CFP:
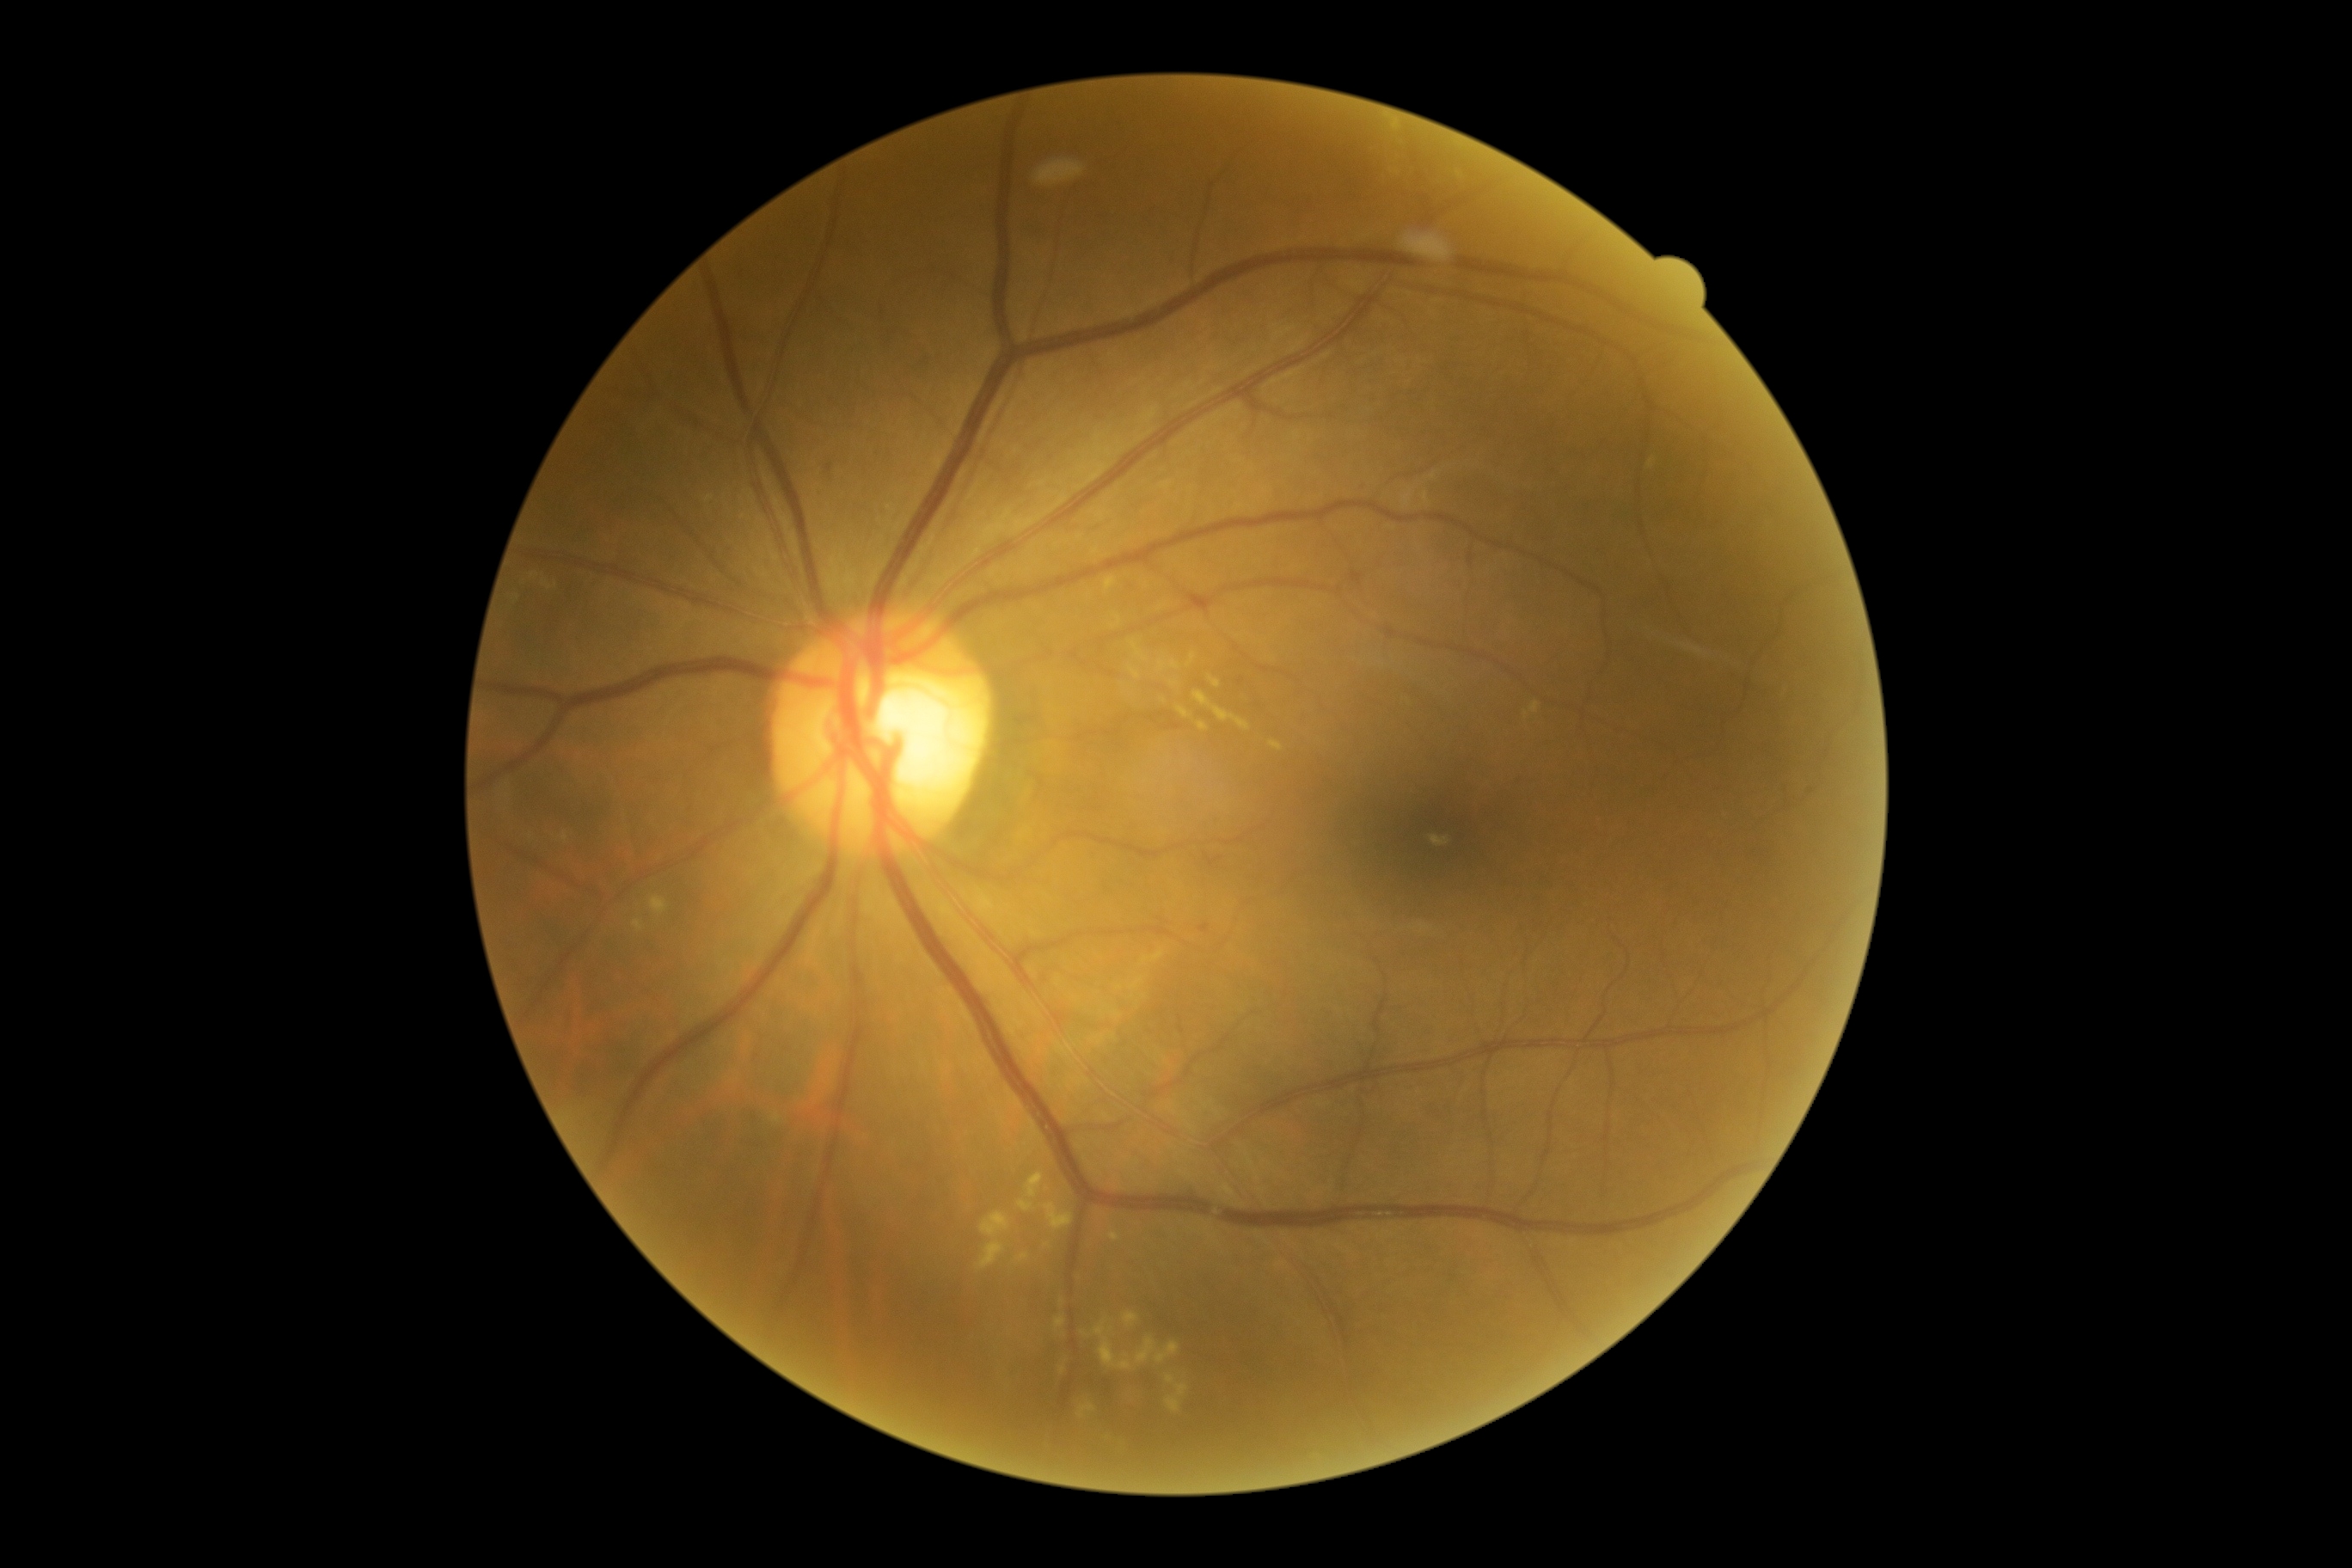
Diabetic retinopathy (DR) is grade 2 (moderate NPDR).